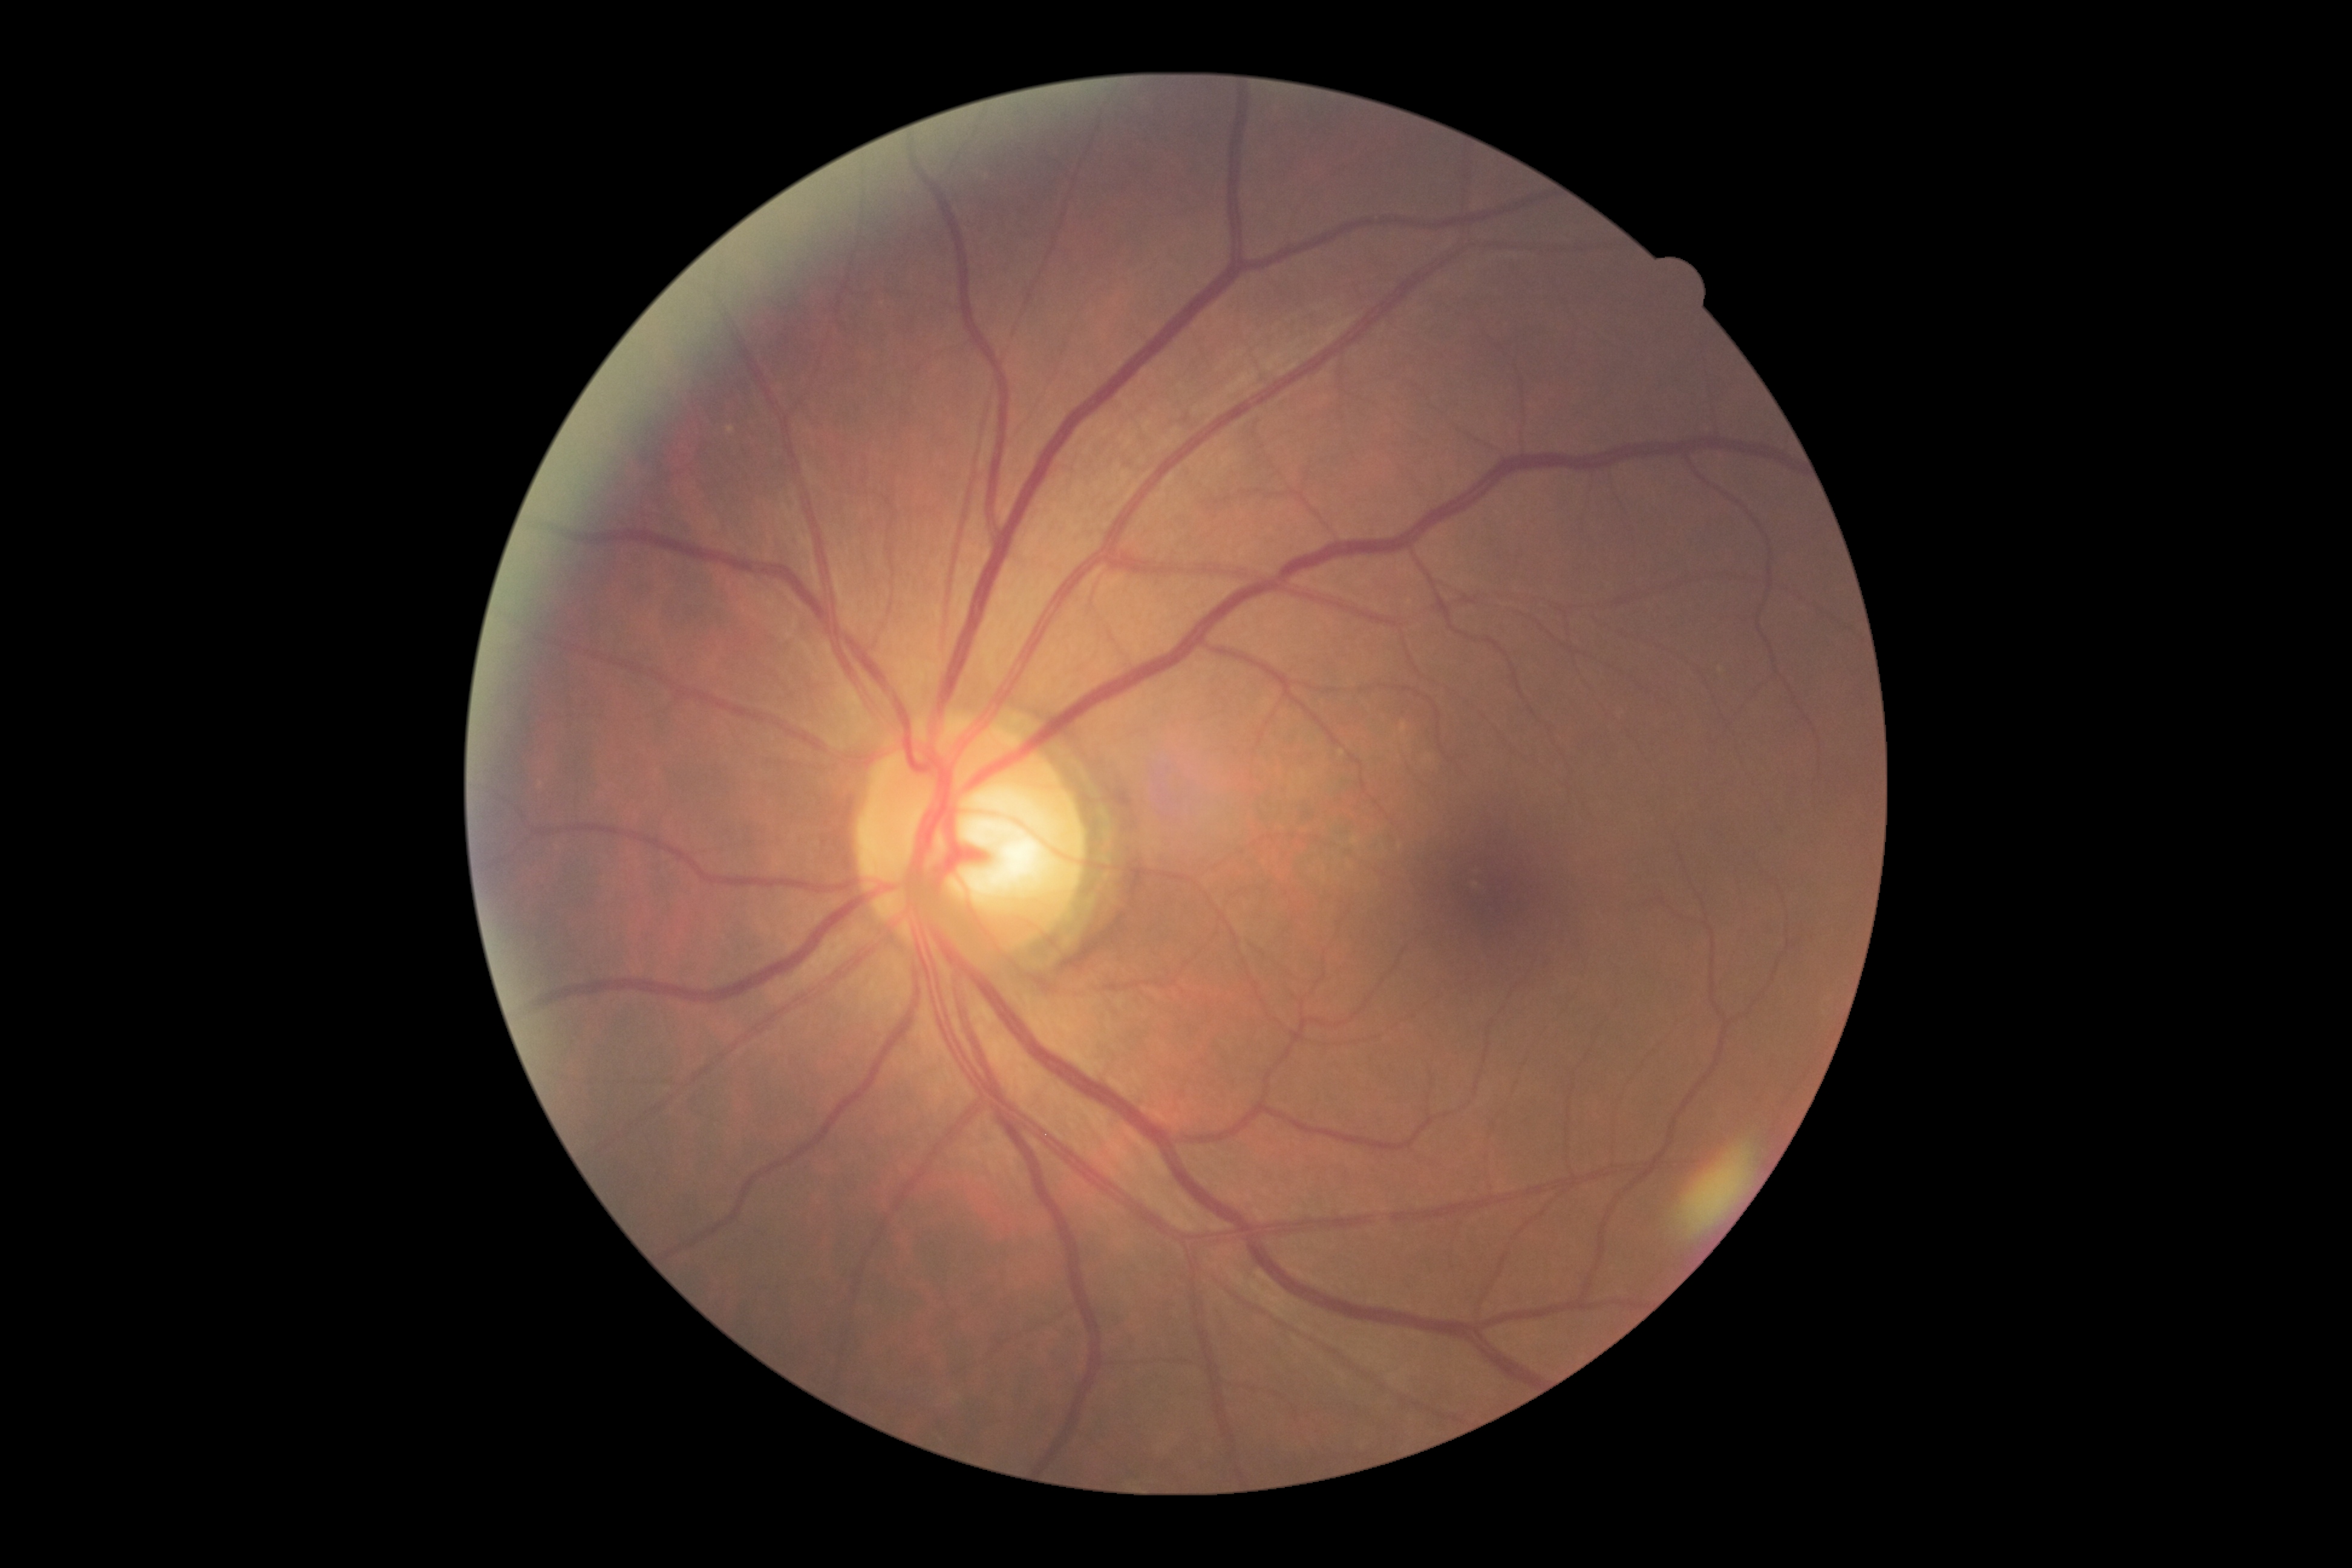 DR: grade 0 (no apparent retinopathy). No apparent diabetic retinopathy.